Color fundus photograph — 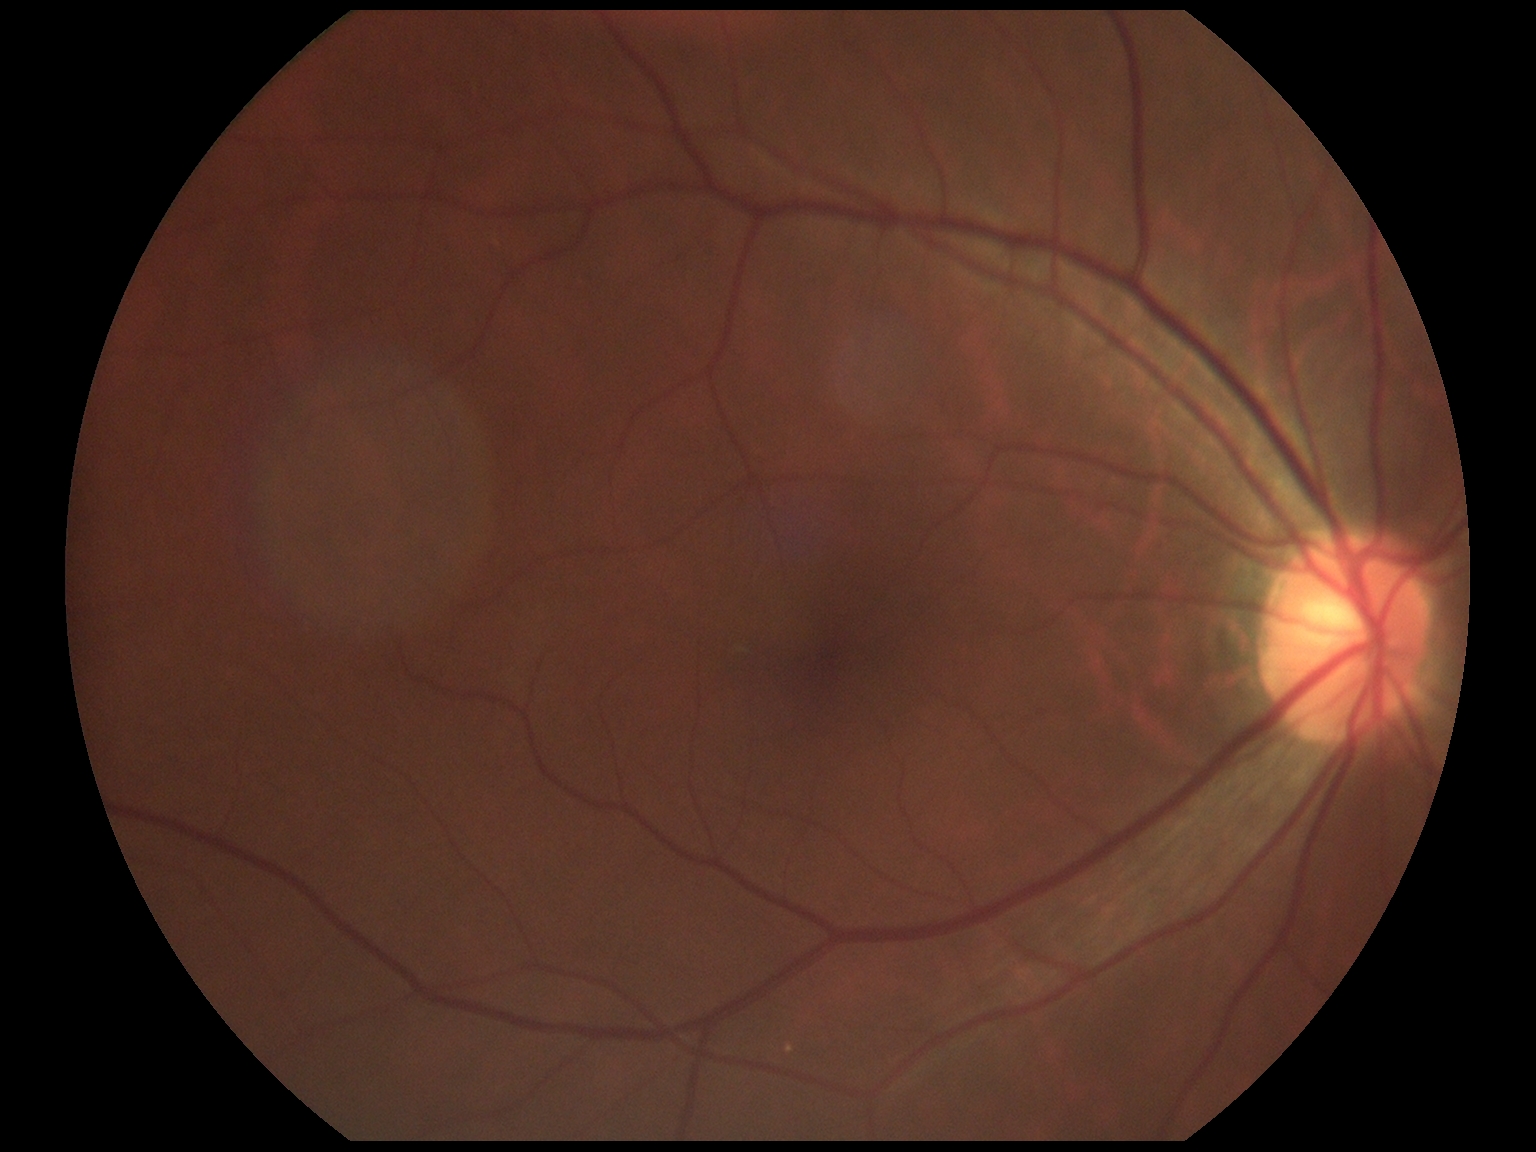 DR severity is grade 0 (no apparent retinopathy) — no visible signs of diabetic retinopathy.